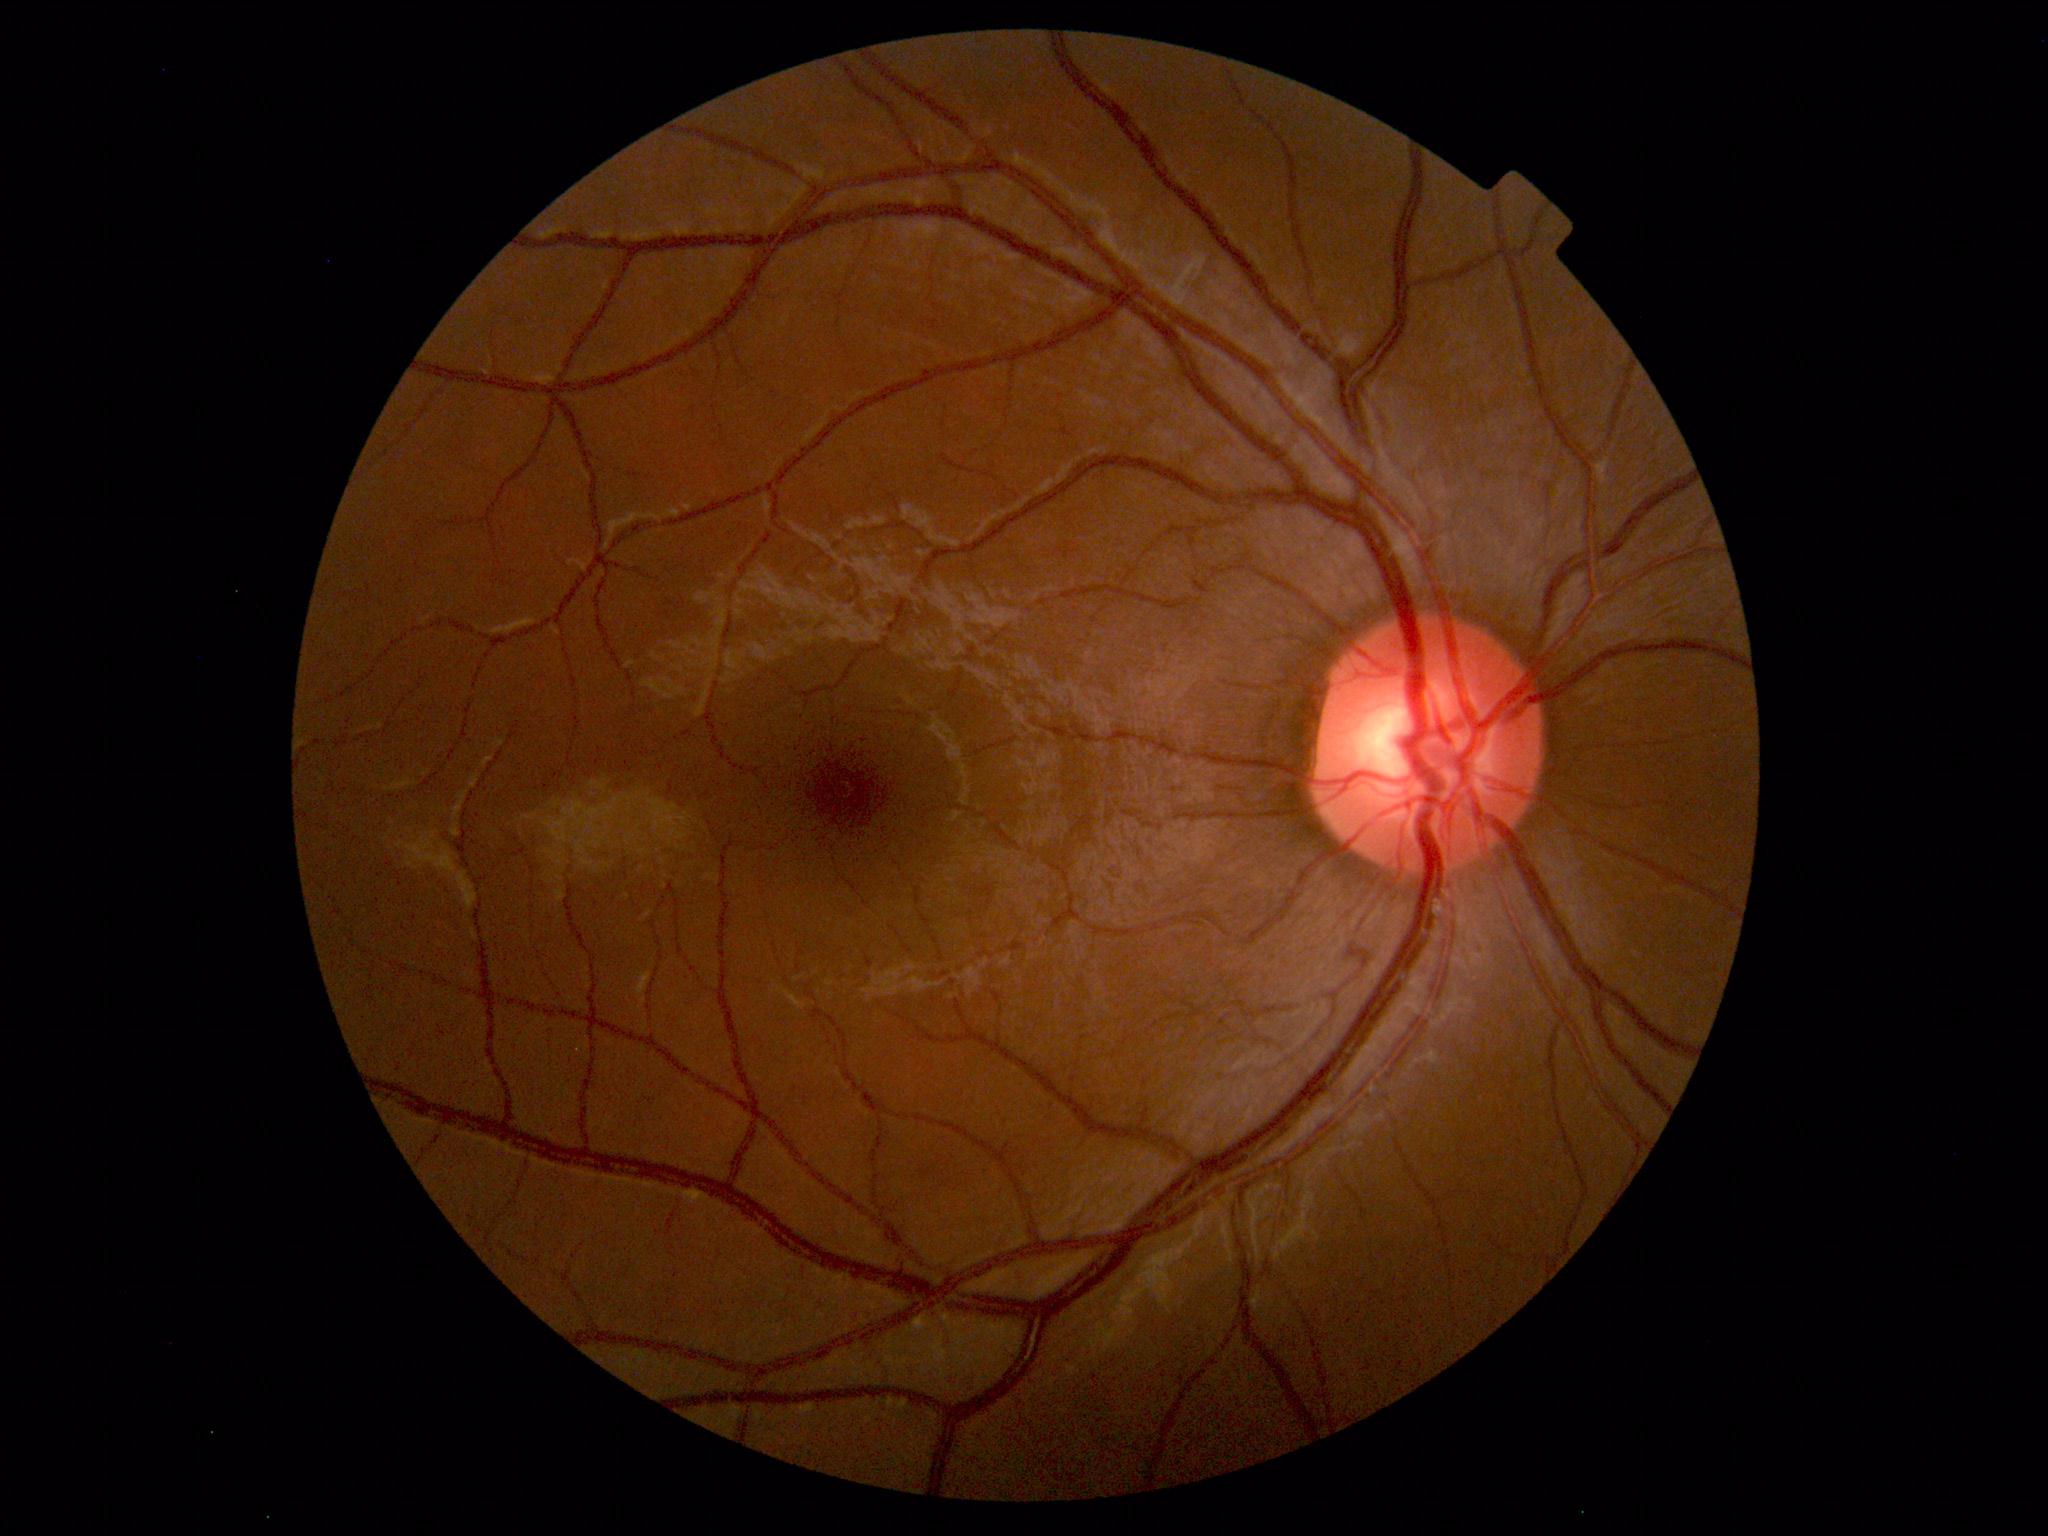 No abnormal findings on fundus examination.